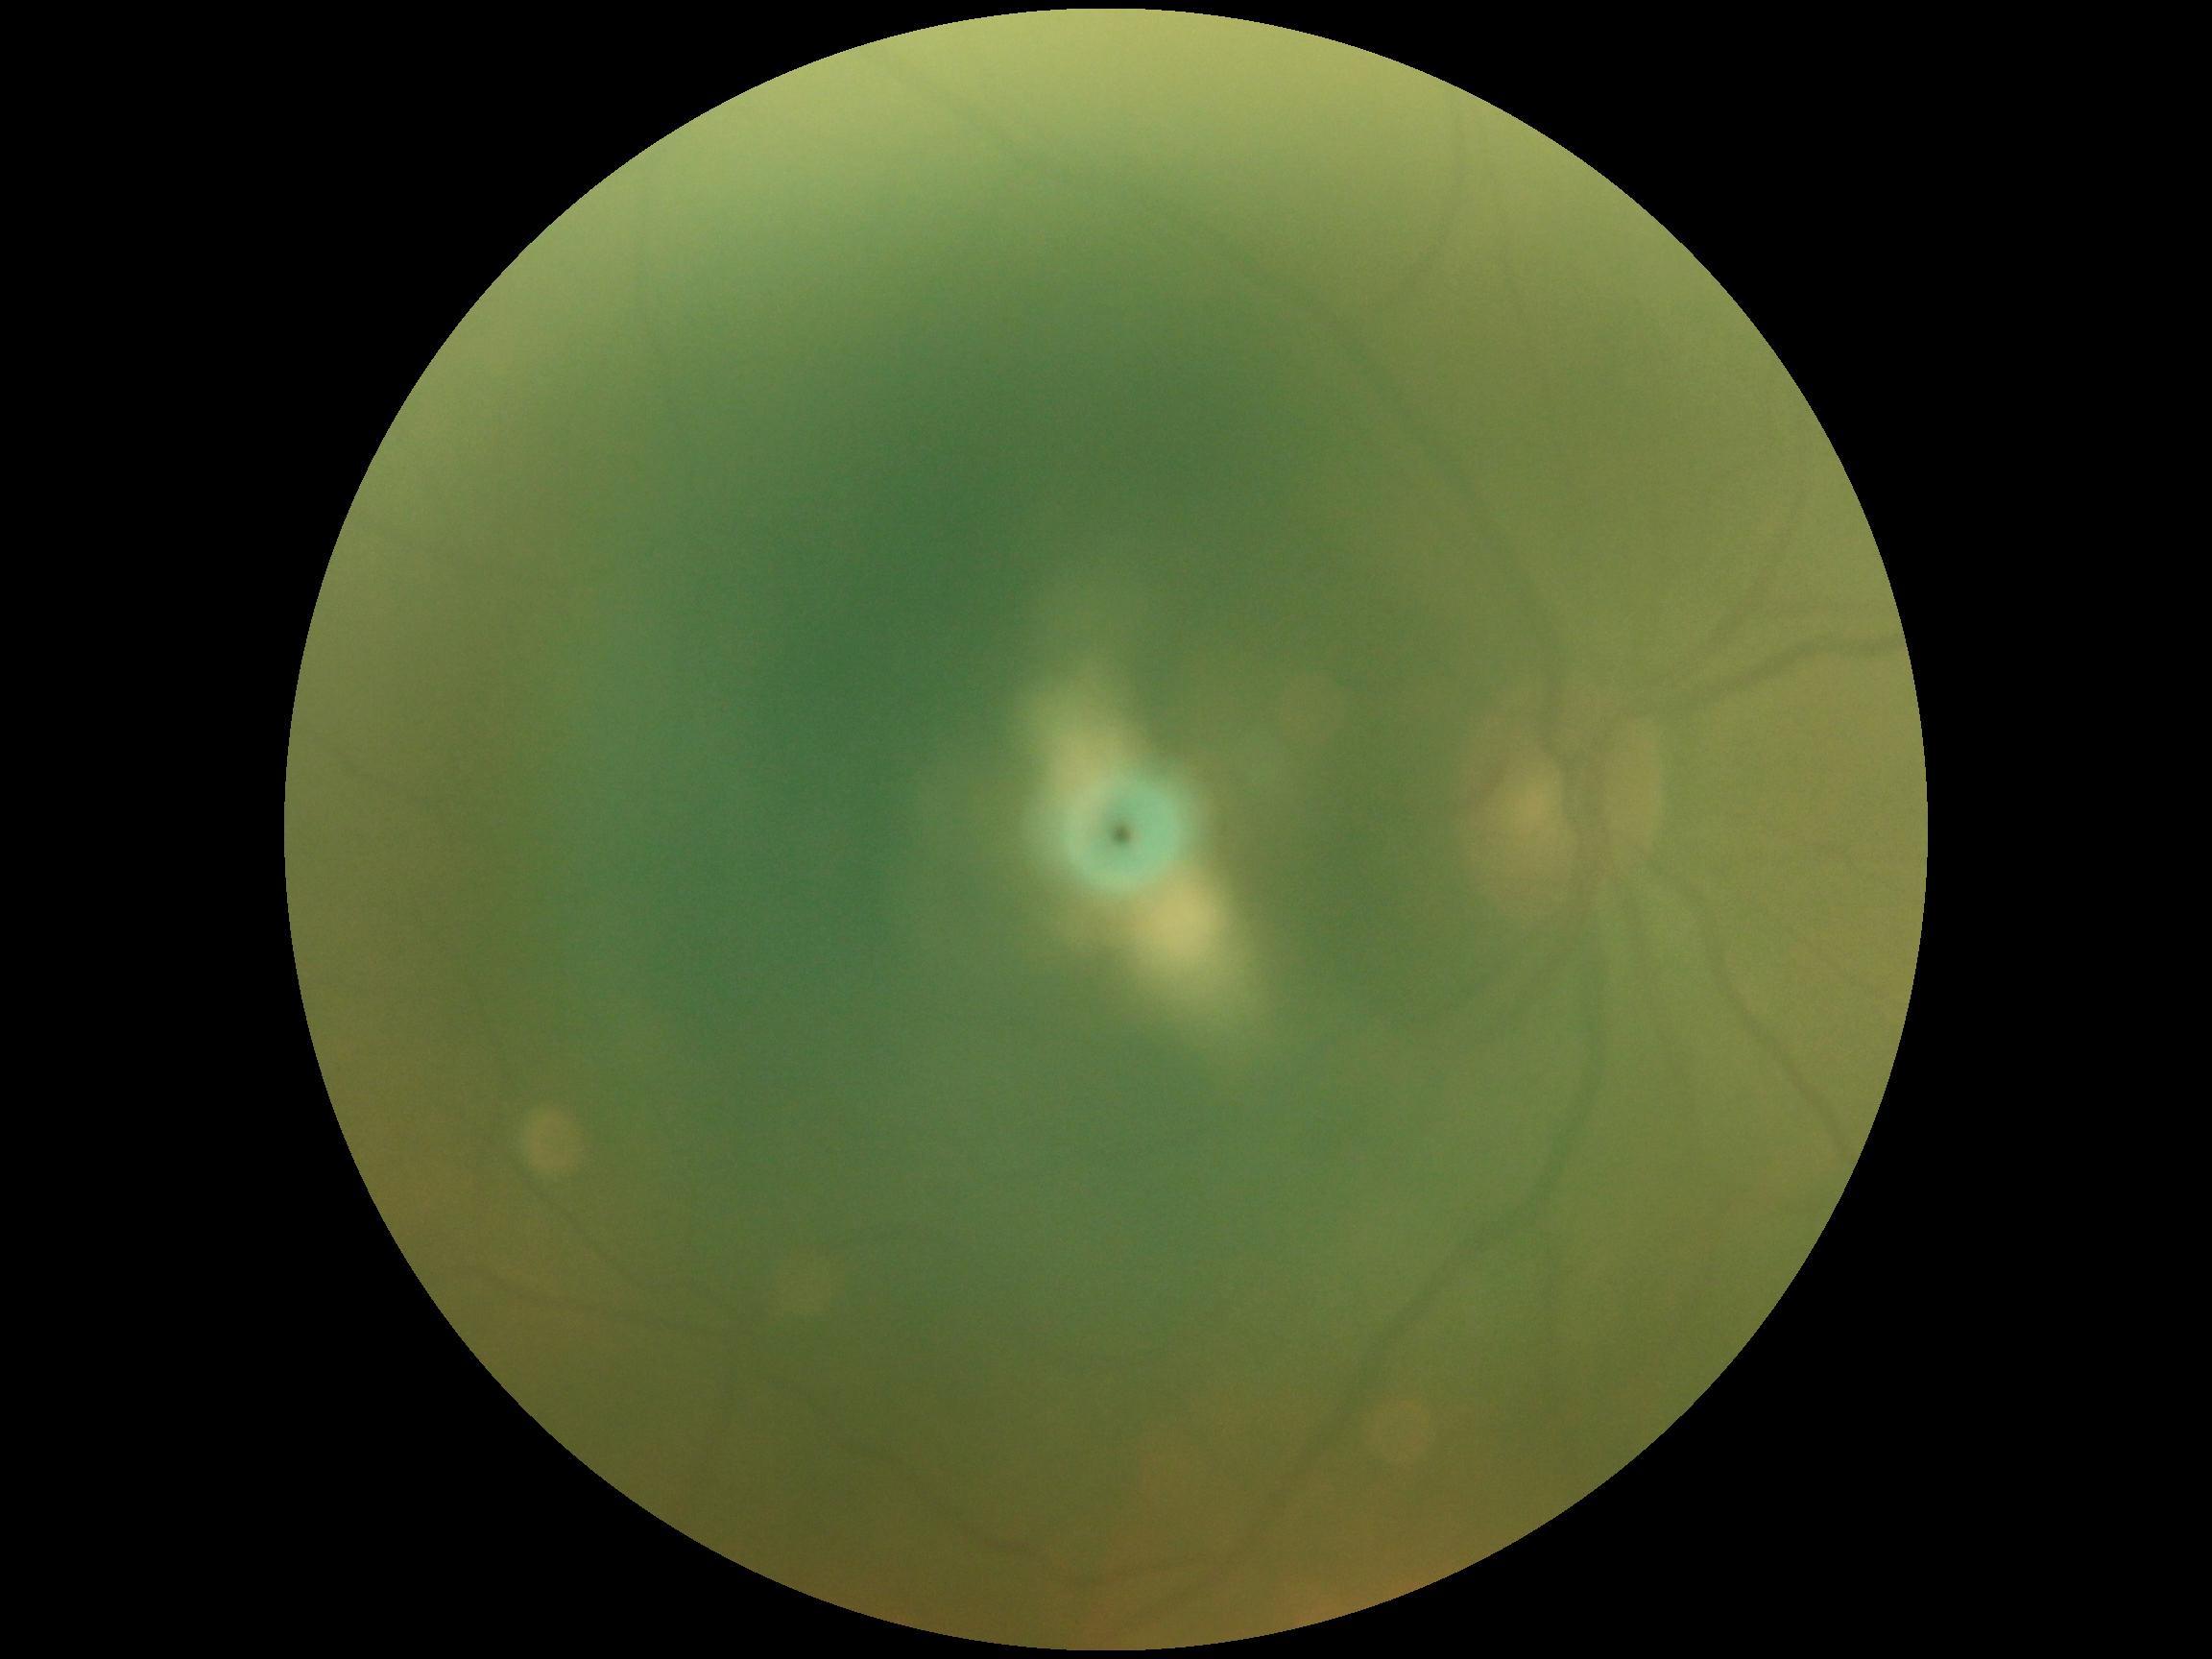

Annotations:
– image quality: too poor for DR grading
– retinopathy: ungradable